Clarity RetCam 3, 130° FOV · pediatric retinal photograph (wide-field) · 640 by 480 pixels:
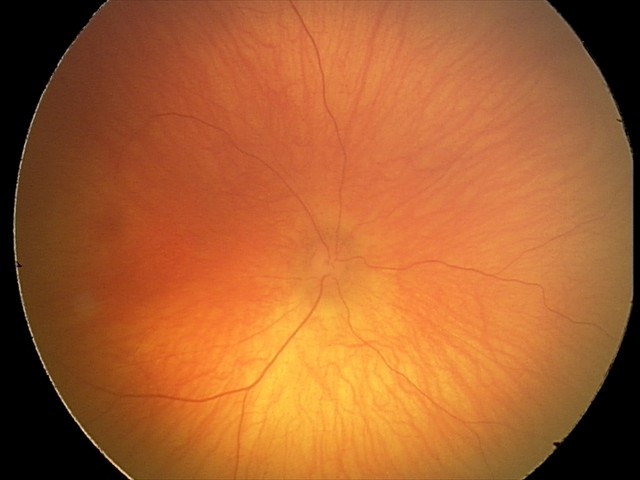

Assessment: no abnormalities.